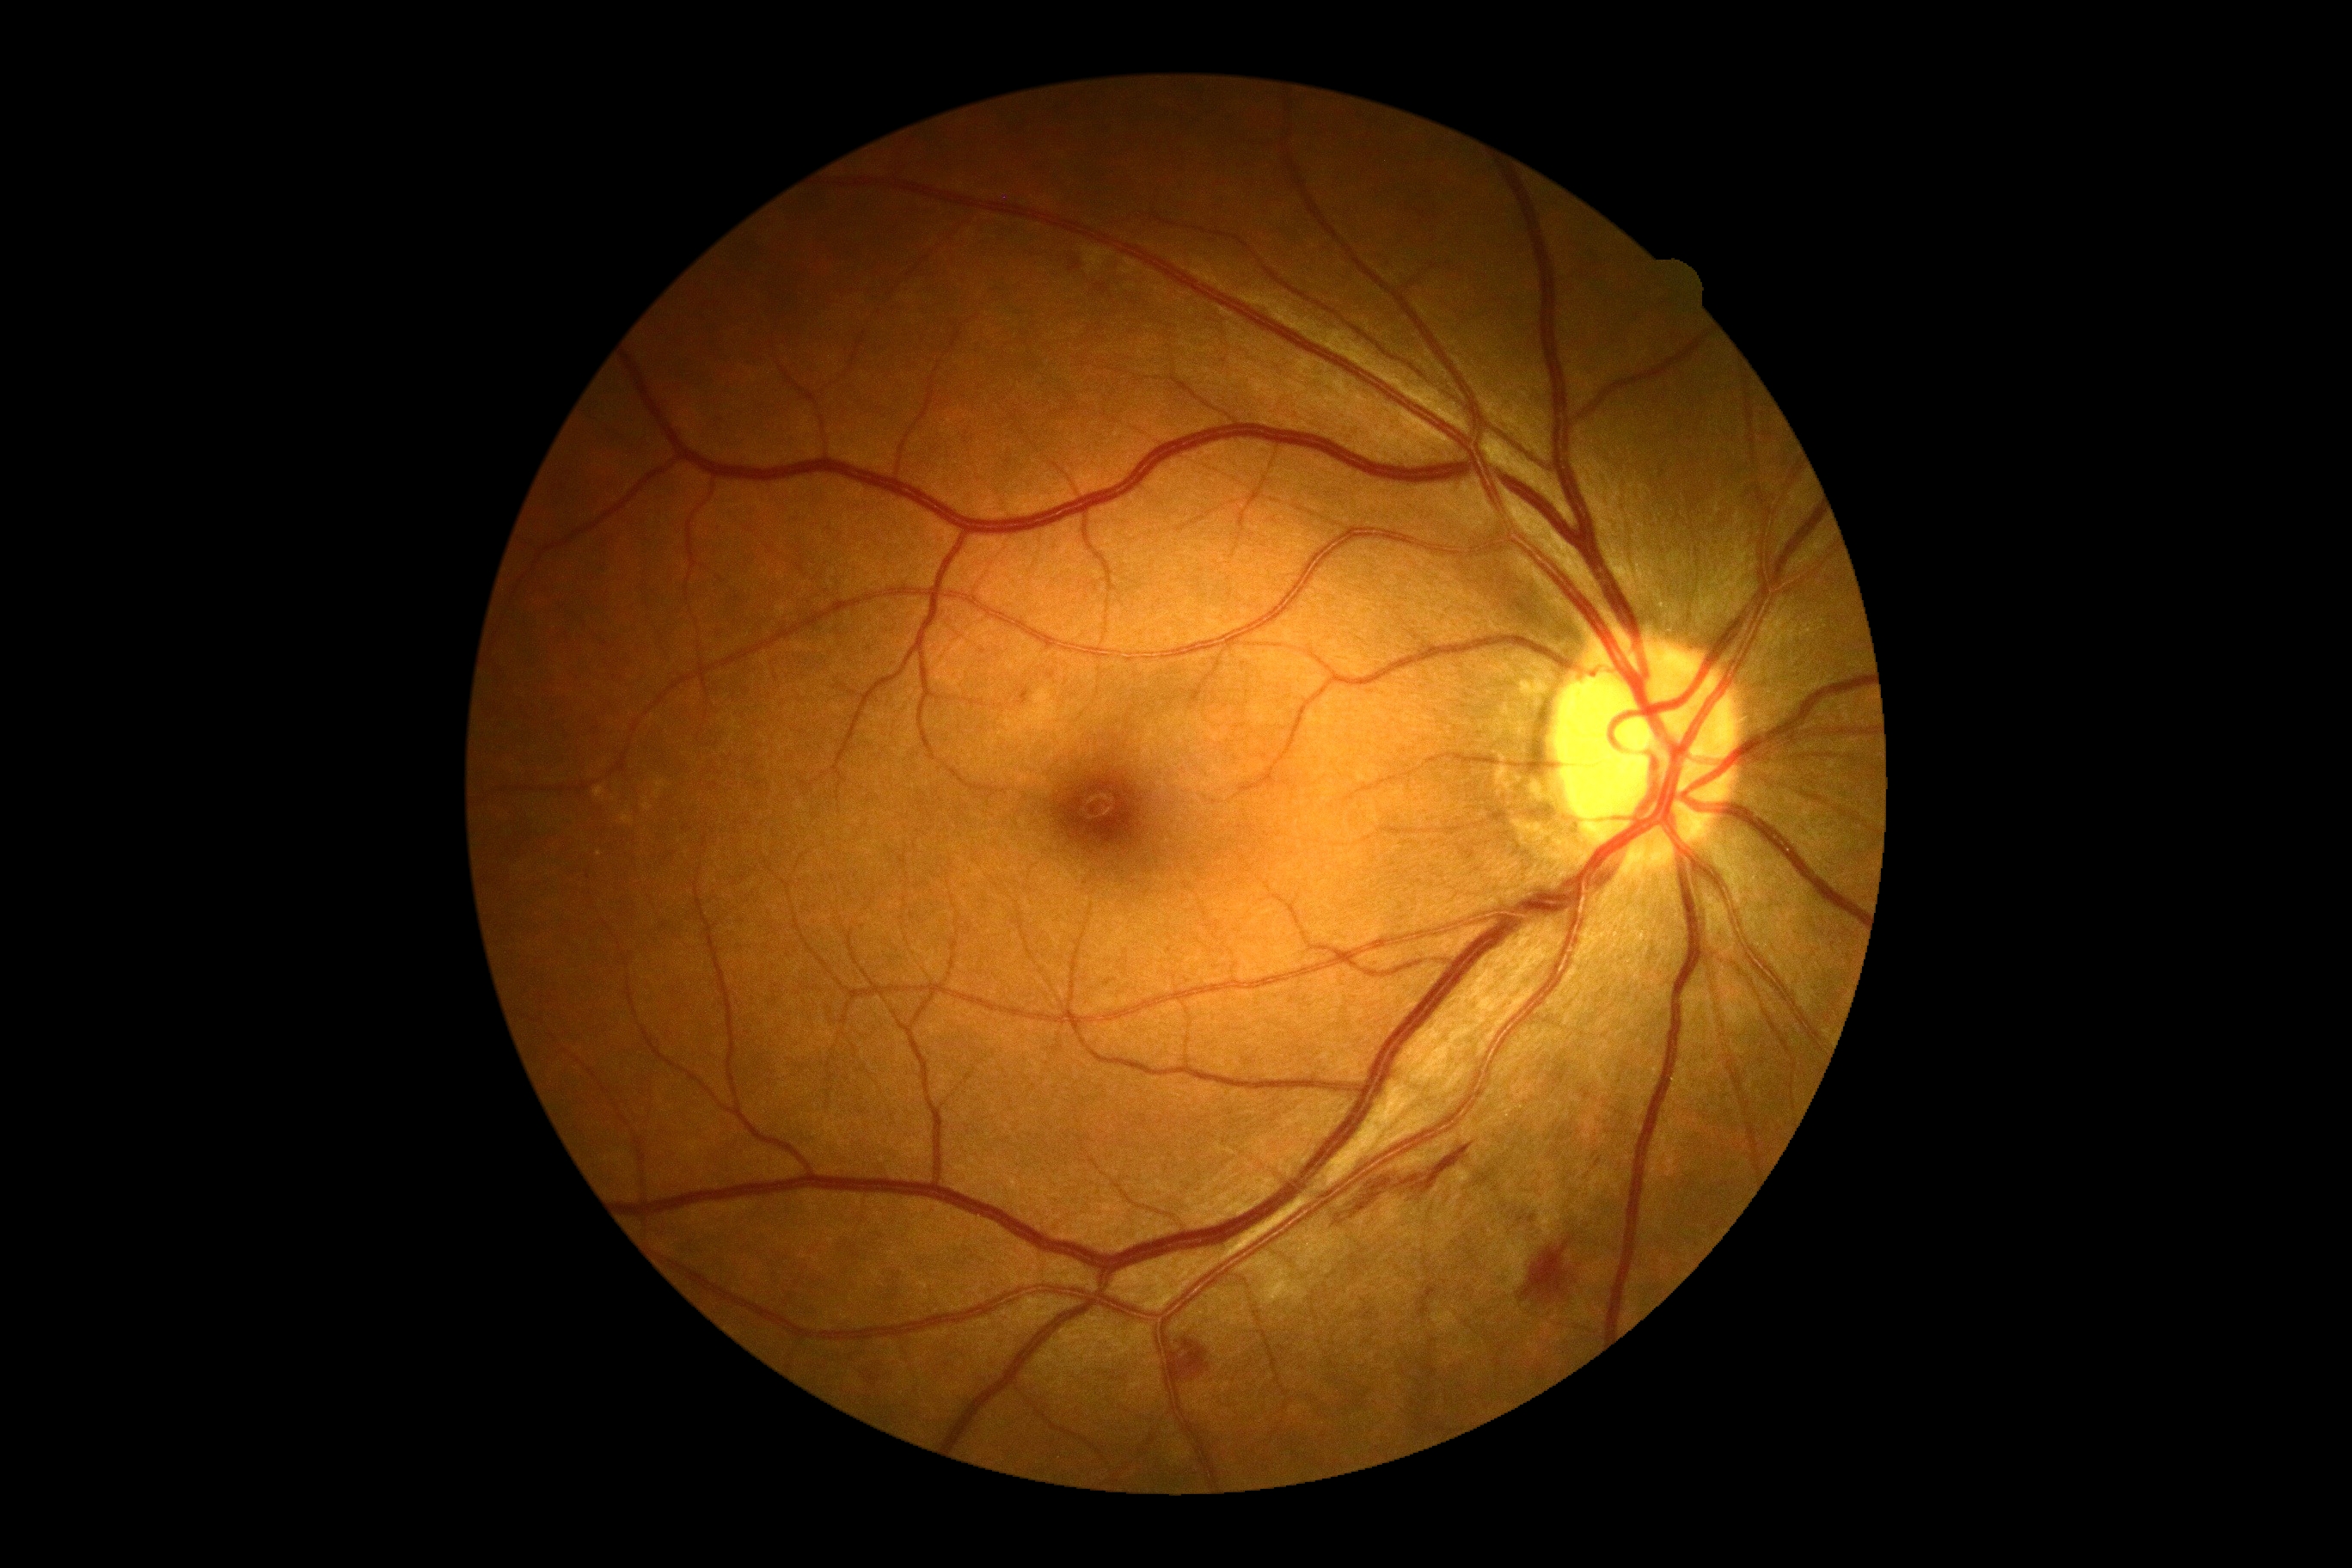 {"dr_grade":2,"lesions":{"ex":null,"ma":[[1529,1215,1536,1223],[1020,689,1029,706]],"ma_small":[[1599,1163]],"he":[[1400,1144,1473,1196],[1521,1239,1572,1302],[1165,1338,1211,1400],[1351,1177,1393,1218],[1069,260,1081,273],[1096,285,1108,295],[869,1375,879,1387]],"he_small":[[869,1373],[864,1377]],"se":null}}